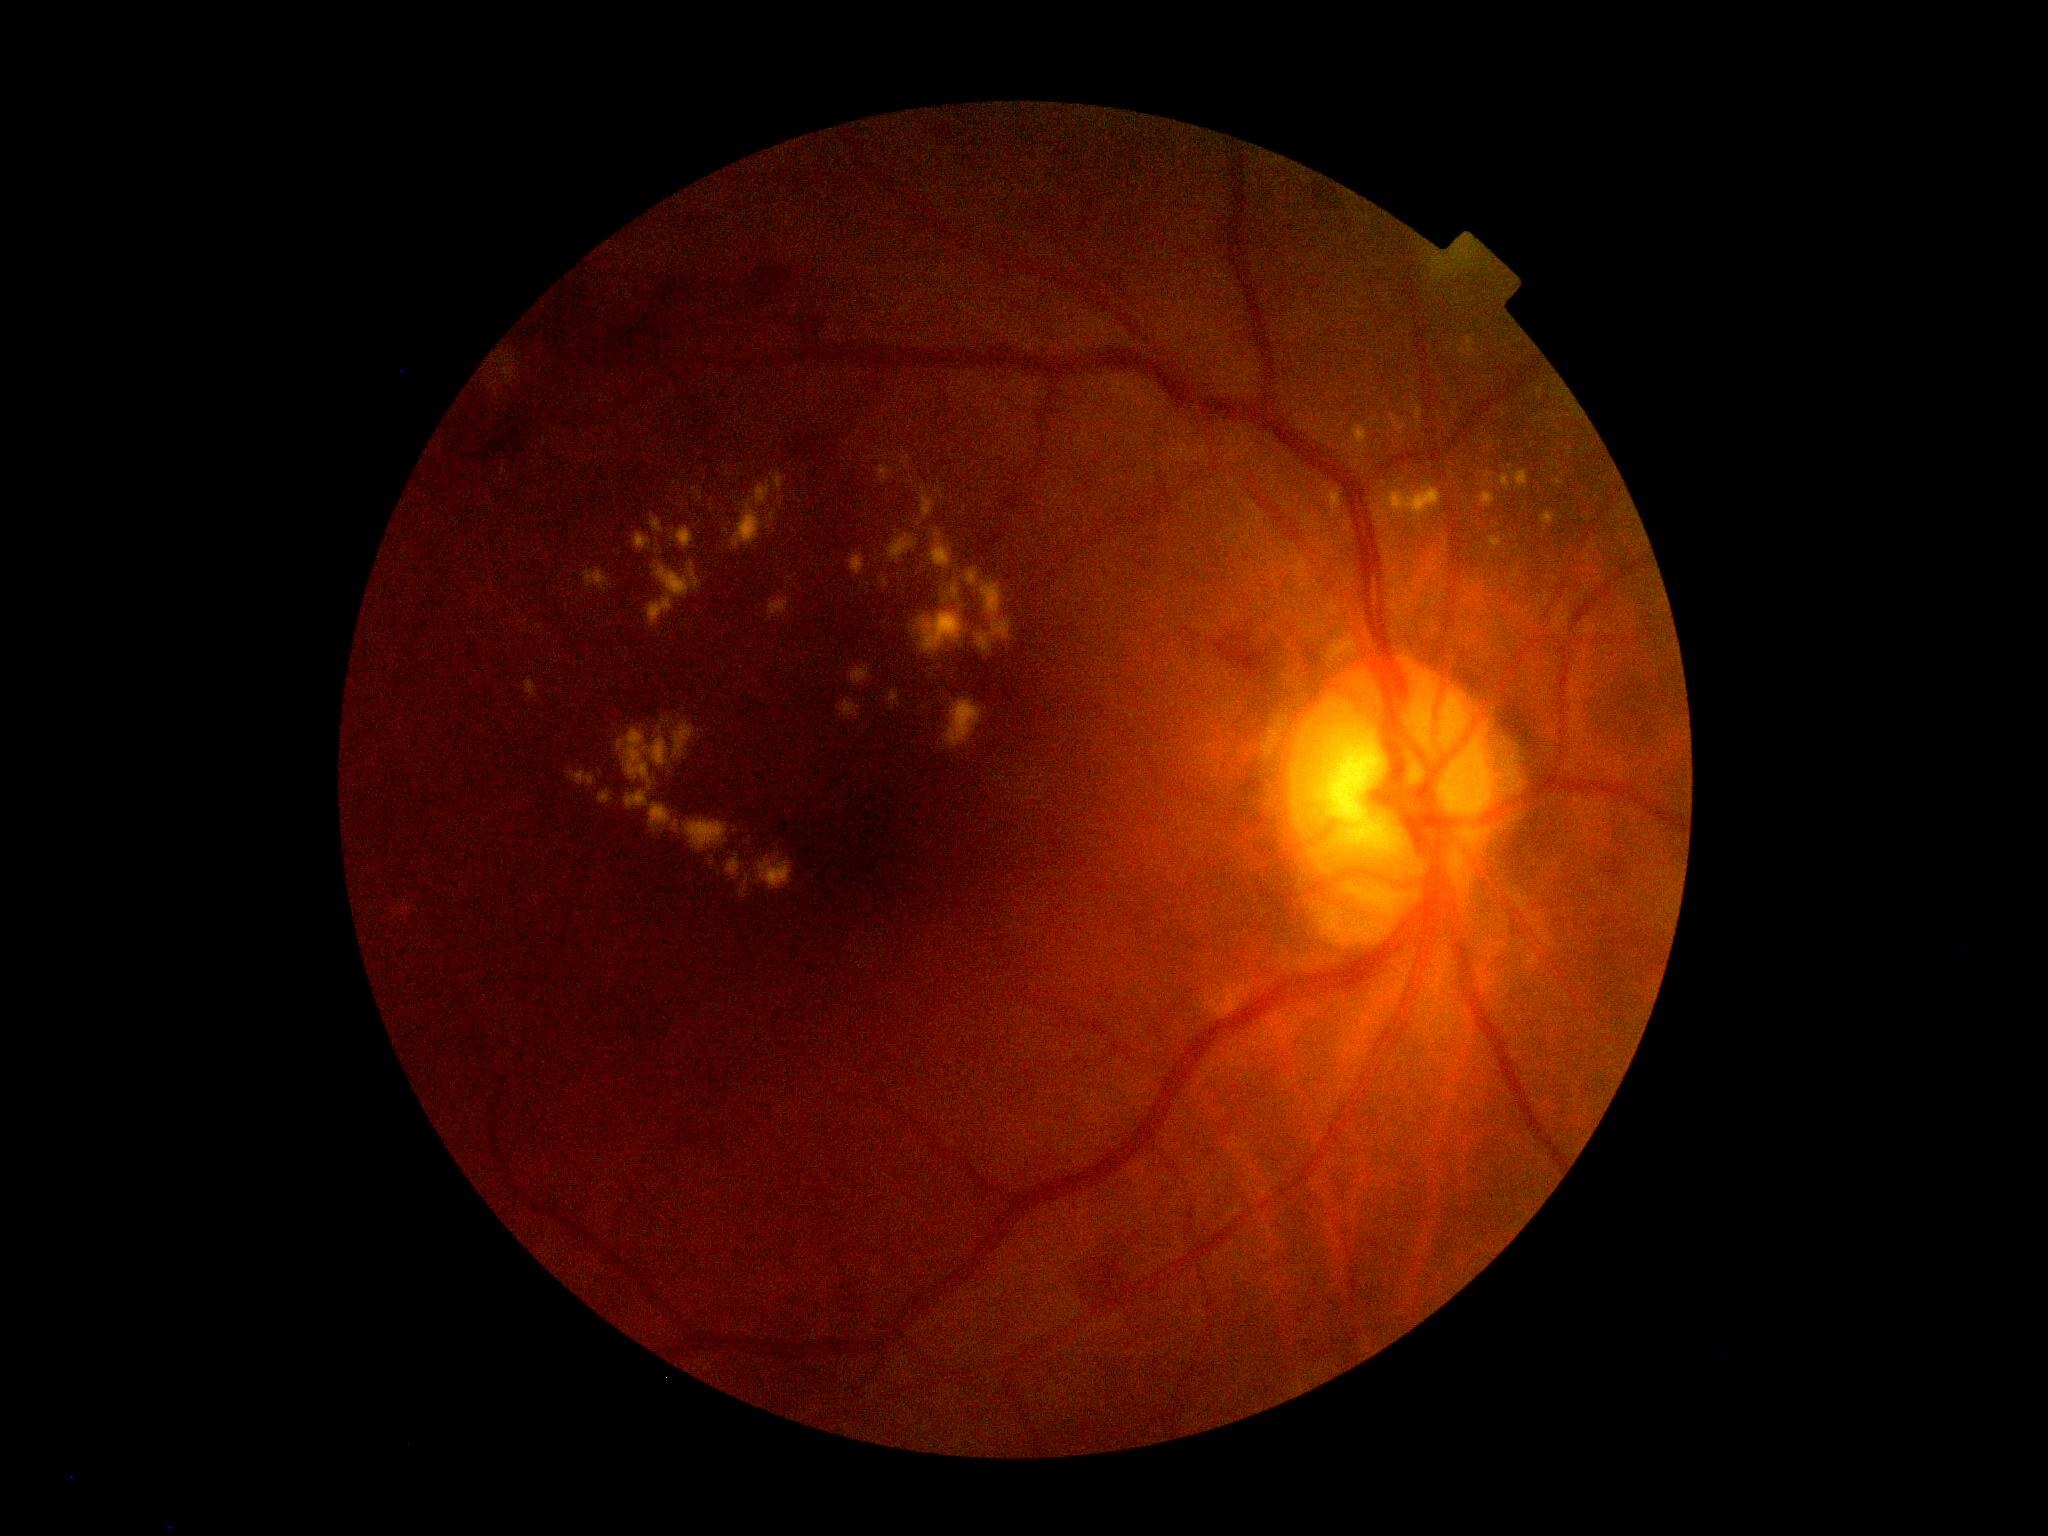 Diabetic retinopathy grade is 2 (moderate NPDR).